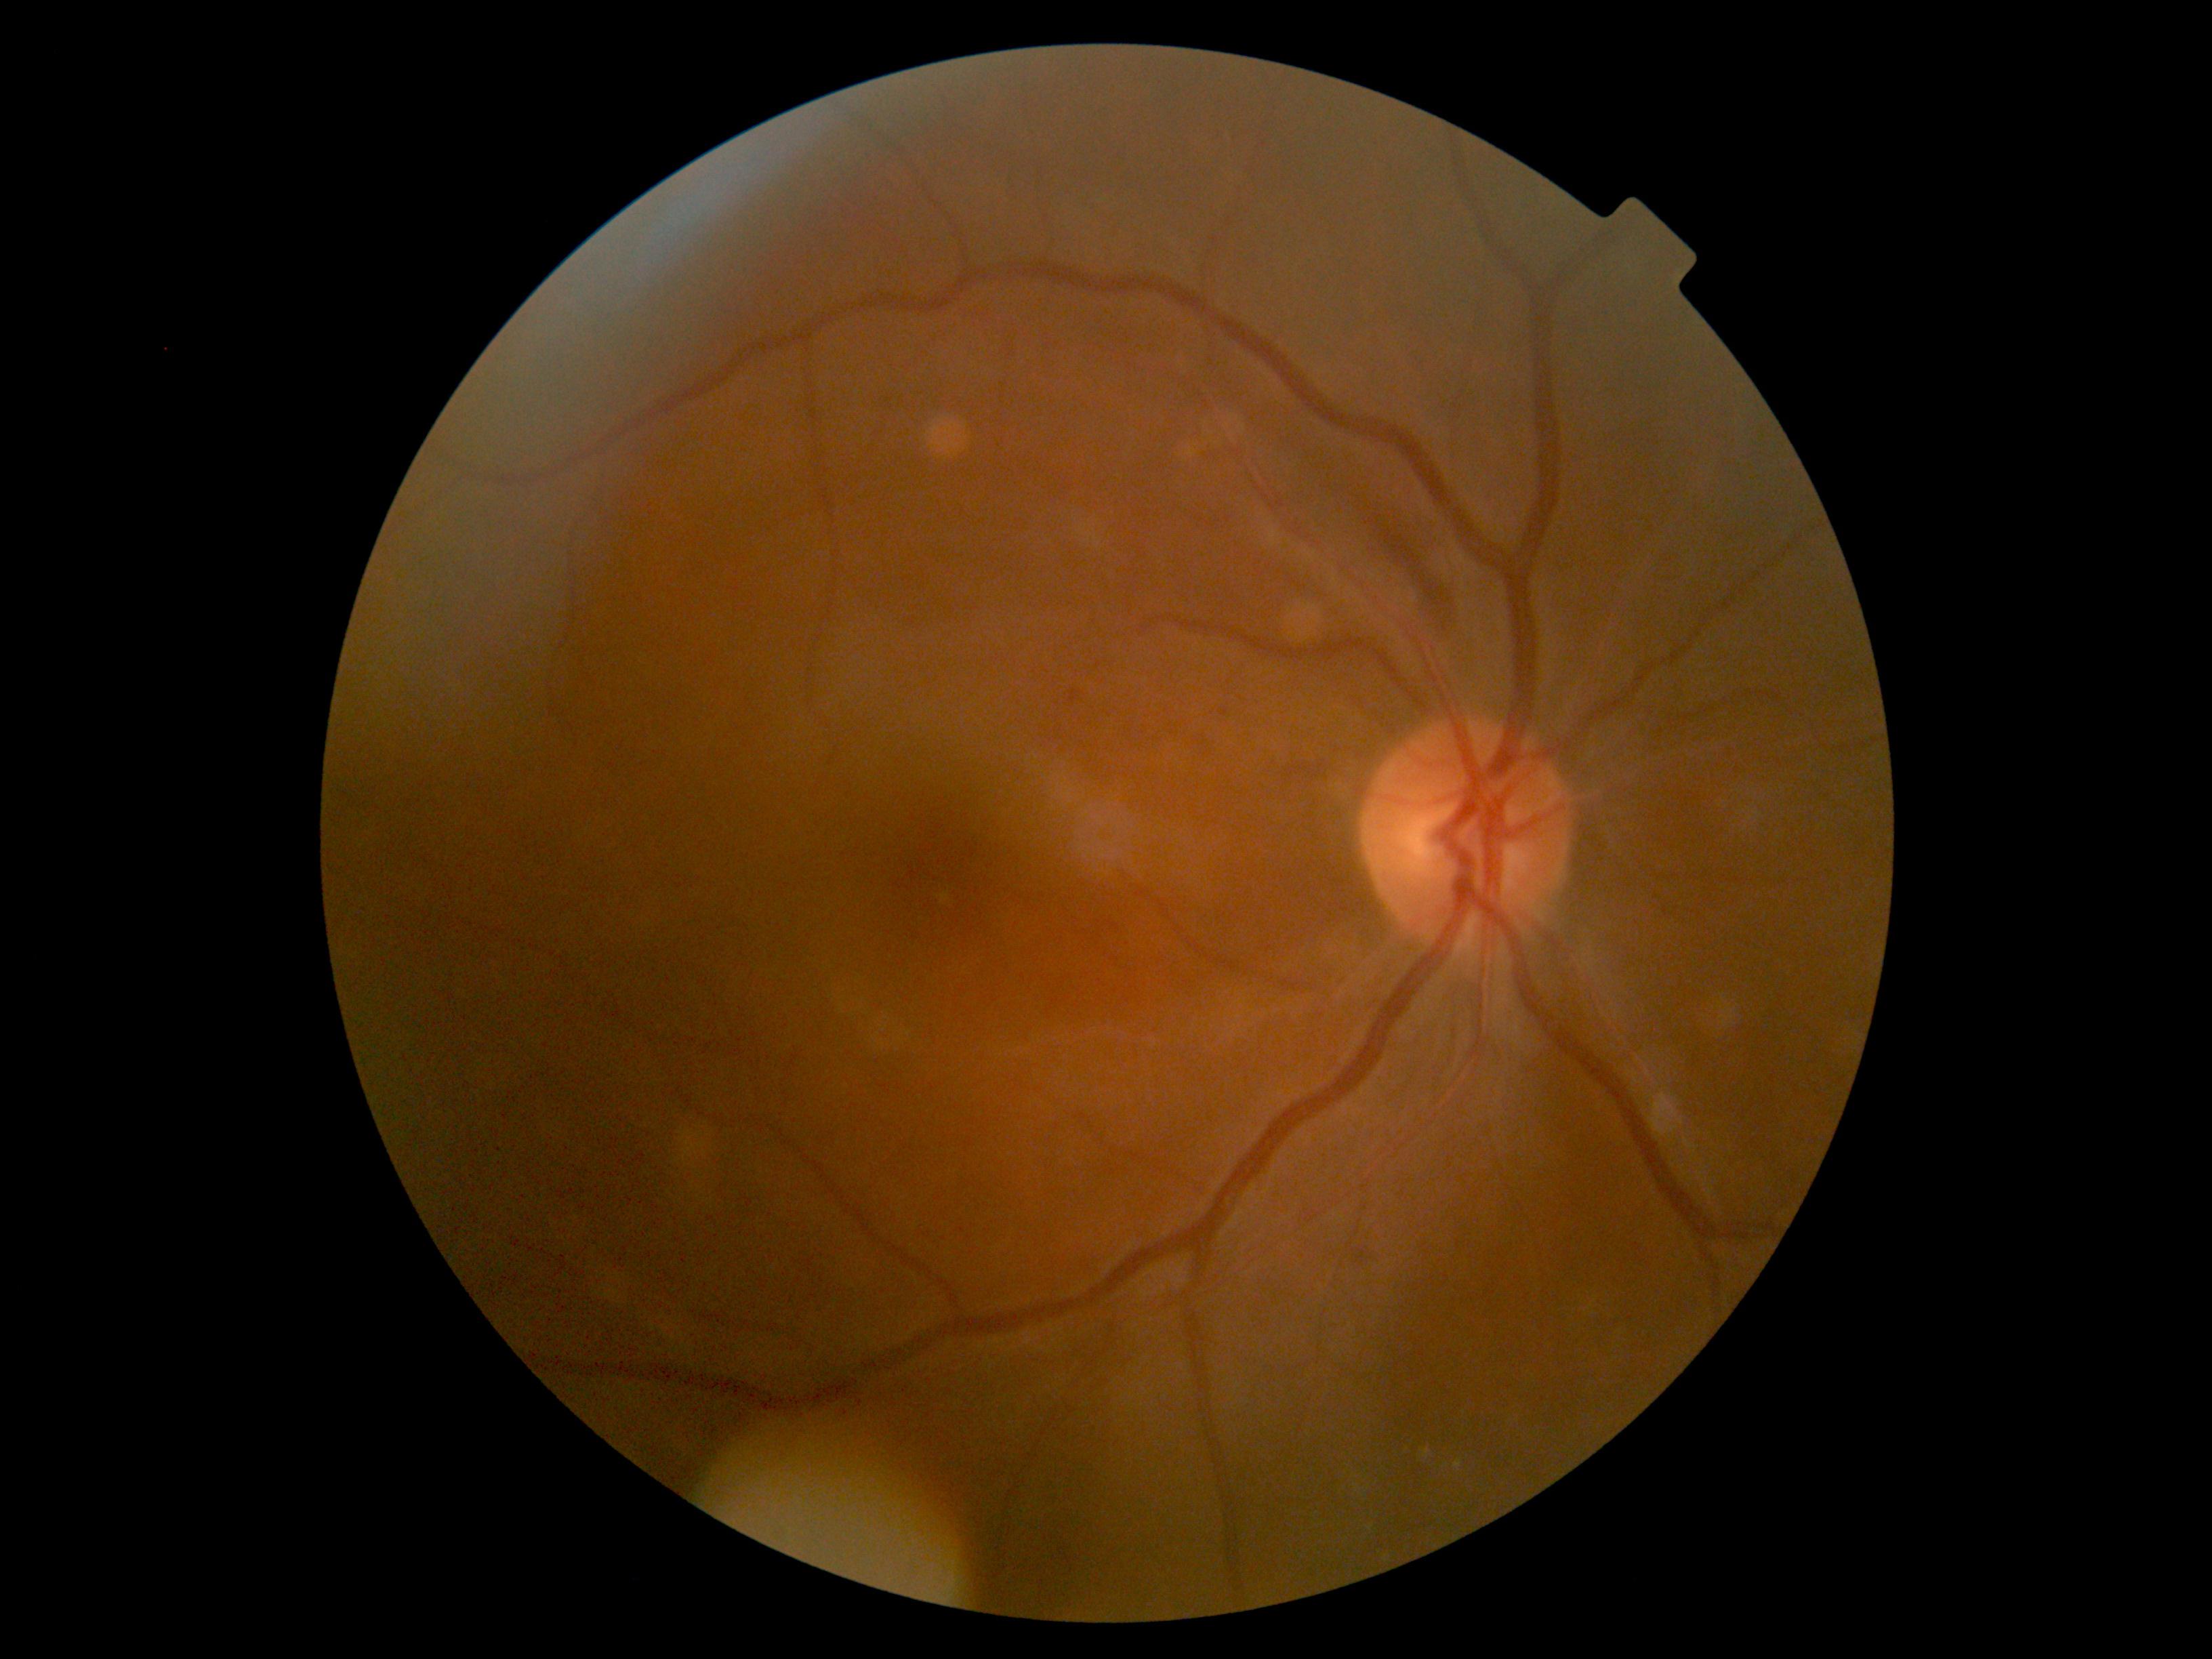
DR stage: 2 — more than just microaneurysms but less than severe NPDR.